45° FOV.
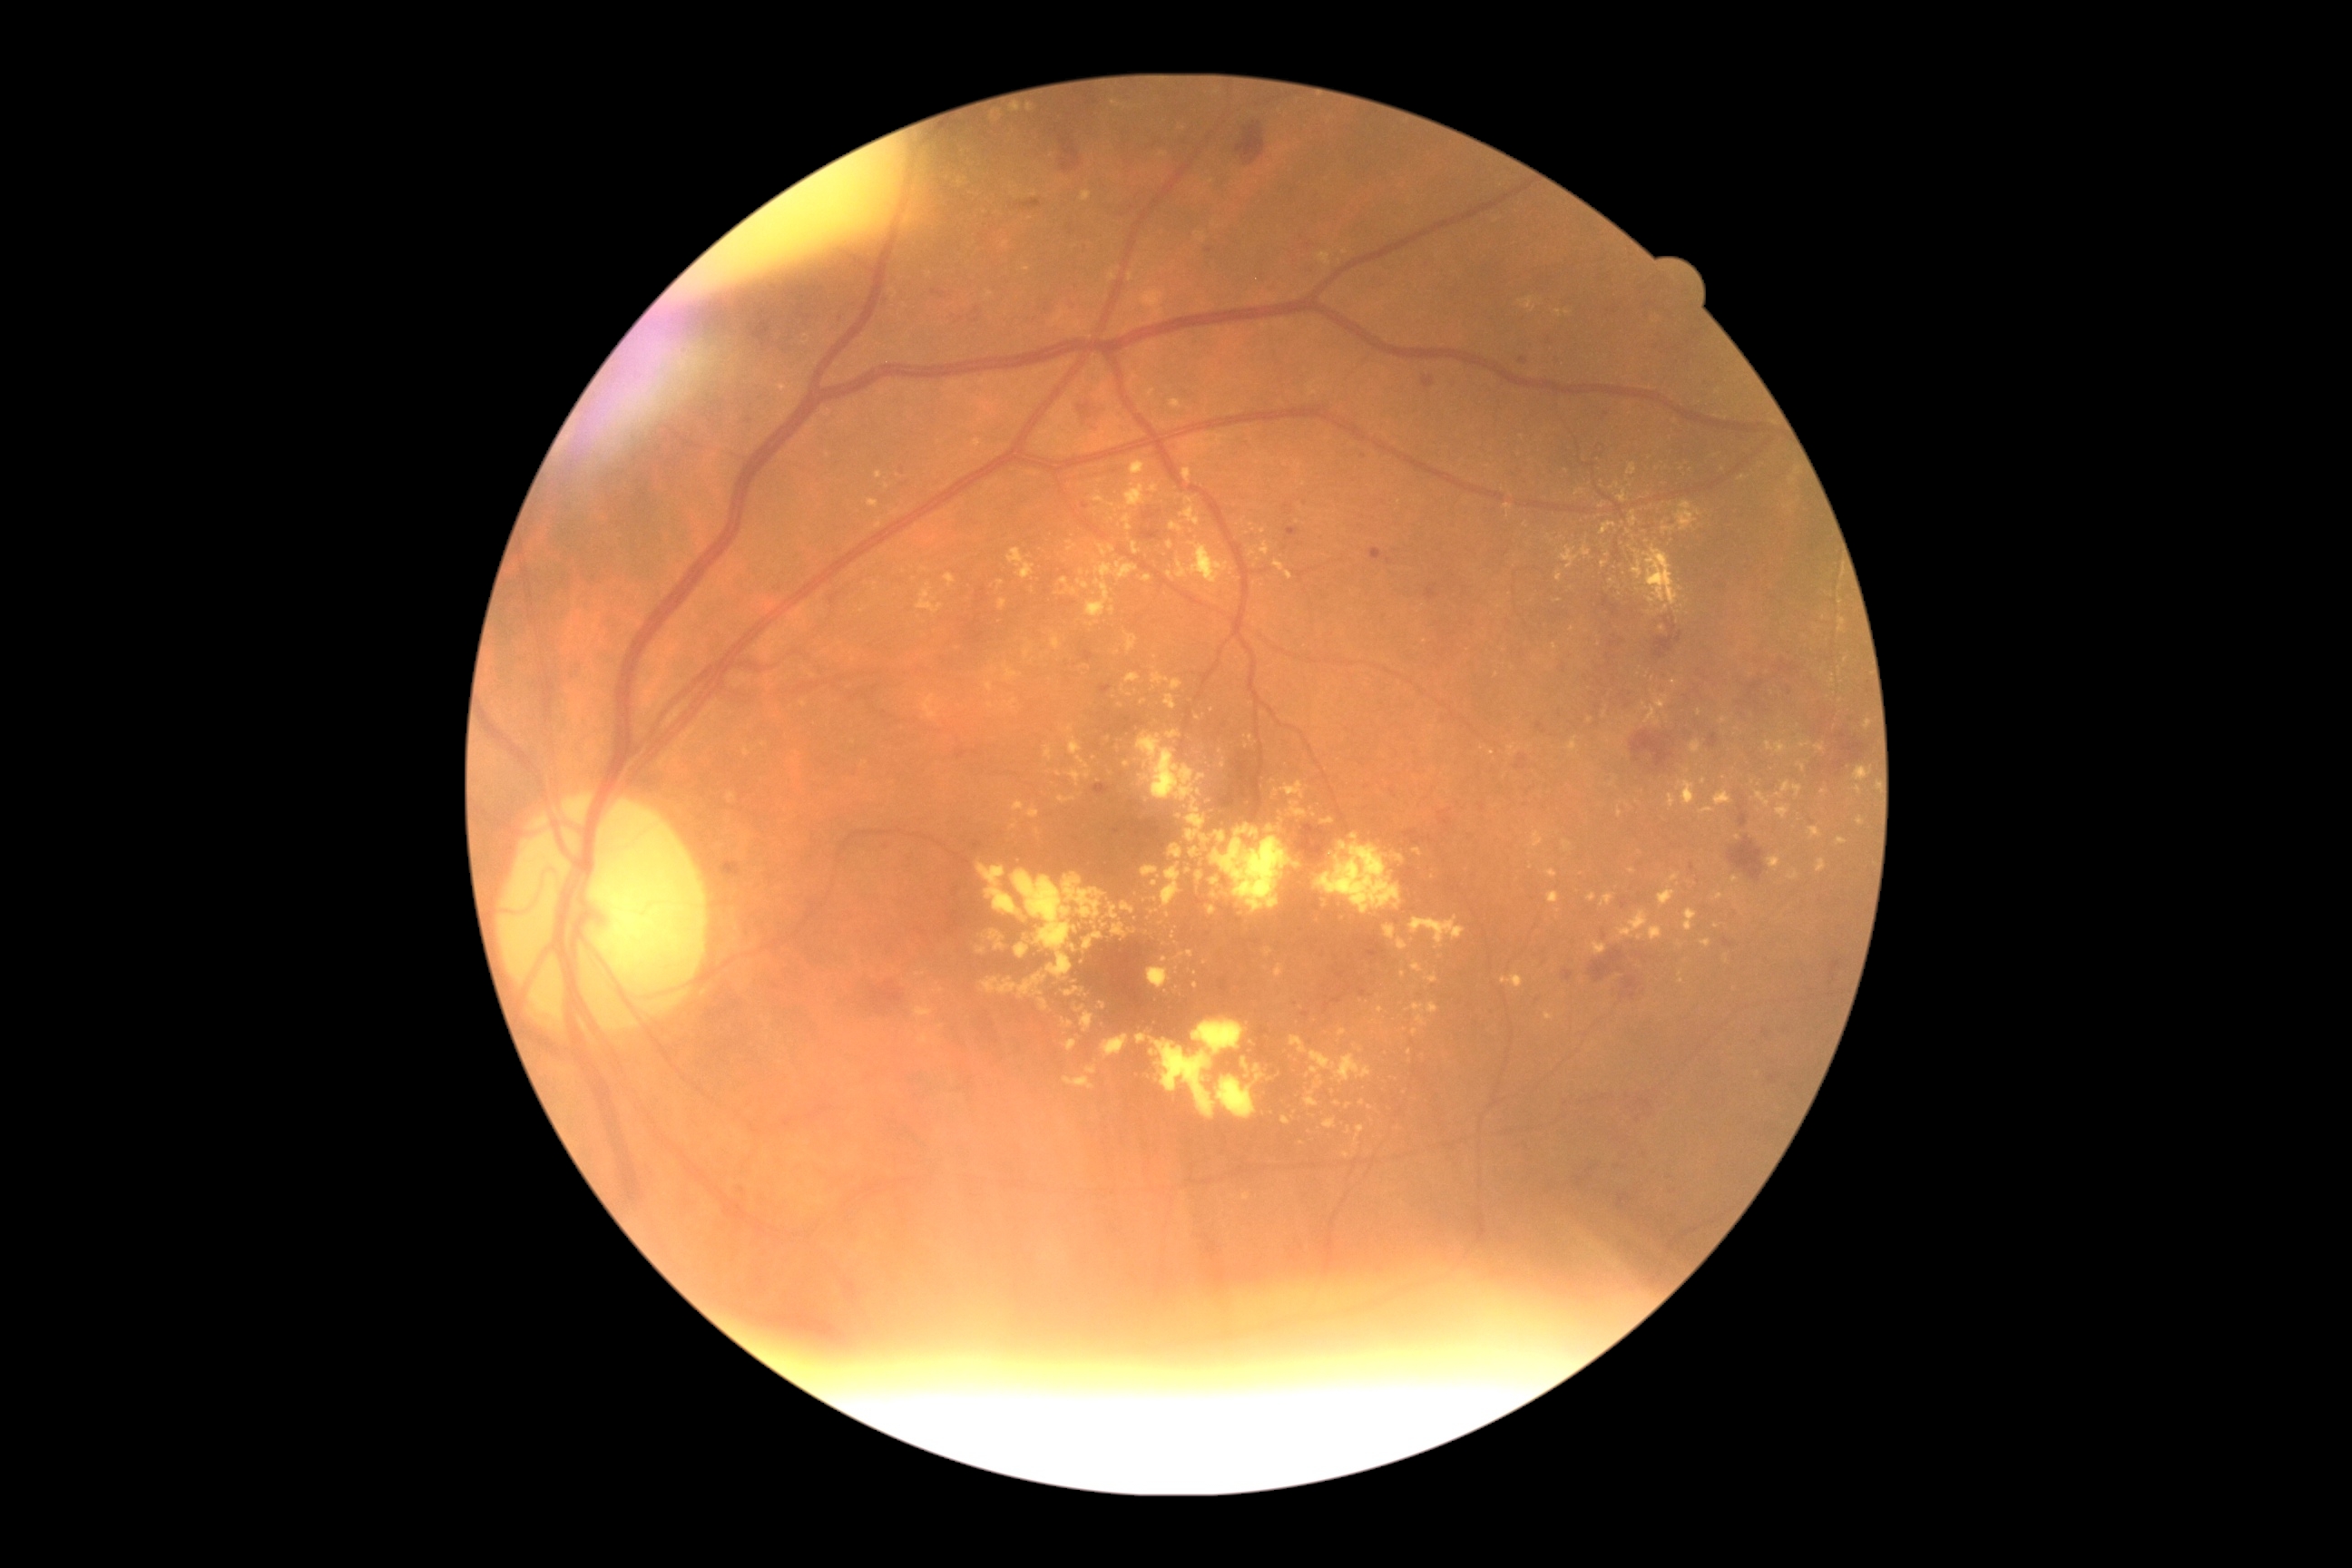

Diabetic retinopathy (DR) is grade 2
Selected lesions:
hard exudates (EXs) (subset) = BBox(1064, 986, 1084, 997), BBox(1175, 544, 1230, 585), BBox(1318, 253, 1331, 266), BBox(727, 794, 738, 805), BBox(979, 210, 988, 219), BBox(1152, 672, 1182, 692), BBox(1068, 542, 1077, 553), BBox(1622, 544, 1631, 551), BBox(1052, 638, 1063, 651), BBox(1865, 720, 1872, 730), BBox(1500, 975, 1524, 988)
Smaller EXs around x=1346, y=252, x=1154, y=884, x=905, y=306, x=1168, y=915, x=1549, y=538, x=984, y=937, x=1859, y=790, x=1533, y=310